Without pupil dilation. Retinal fundus photograph — 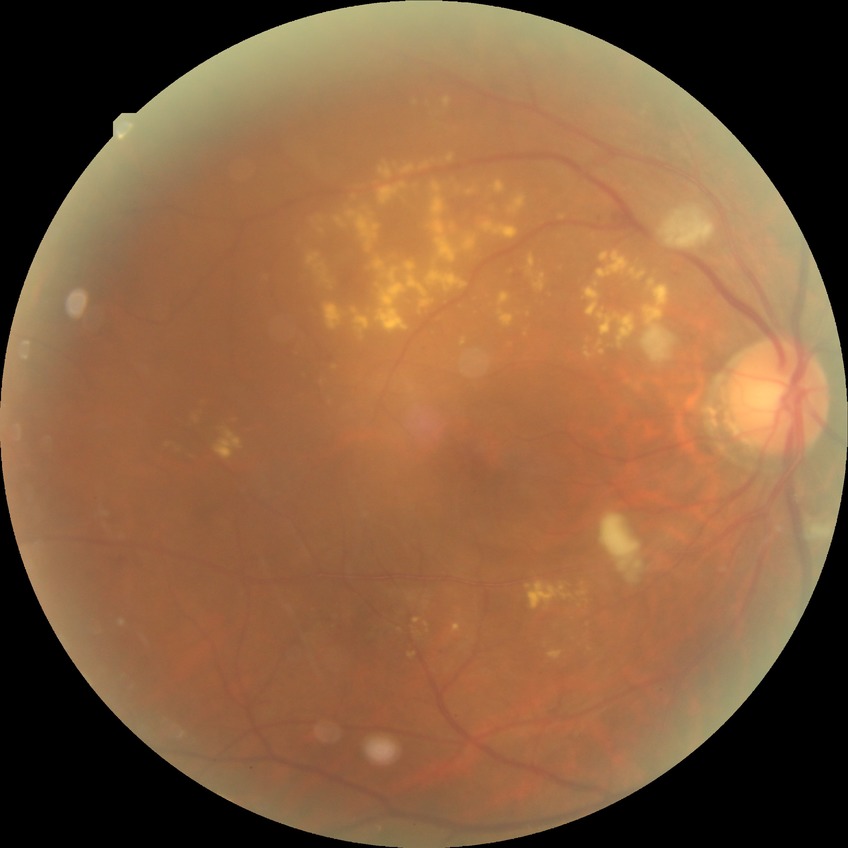

Diabetic retinopathy (DR): pre-proliferative diabetic retinopathy (PPDR). Disease class: non-proliferative diabetic retinopathy.